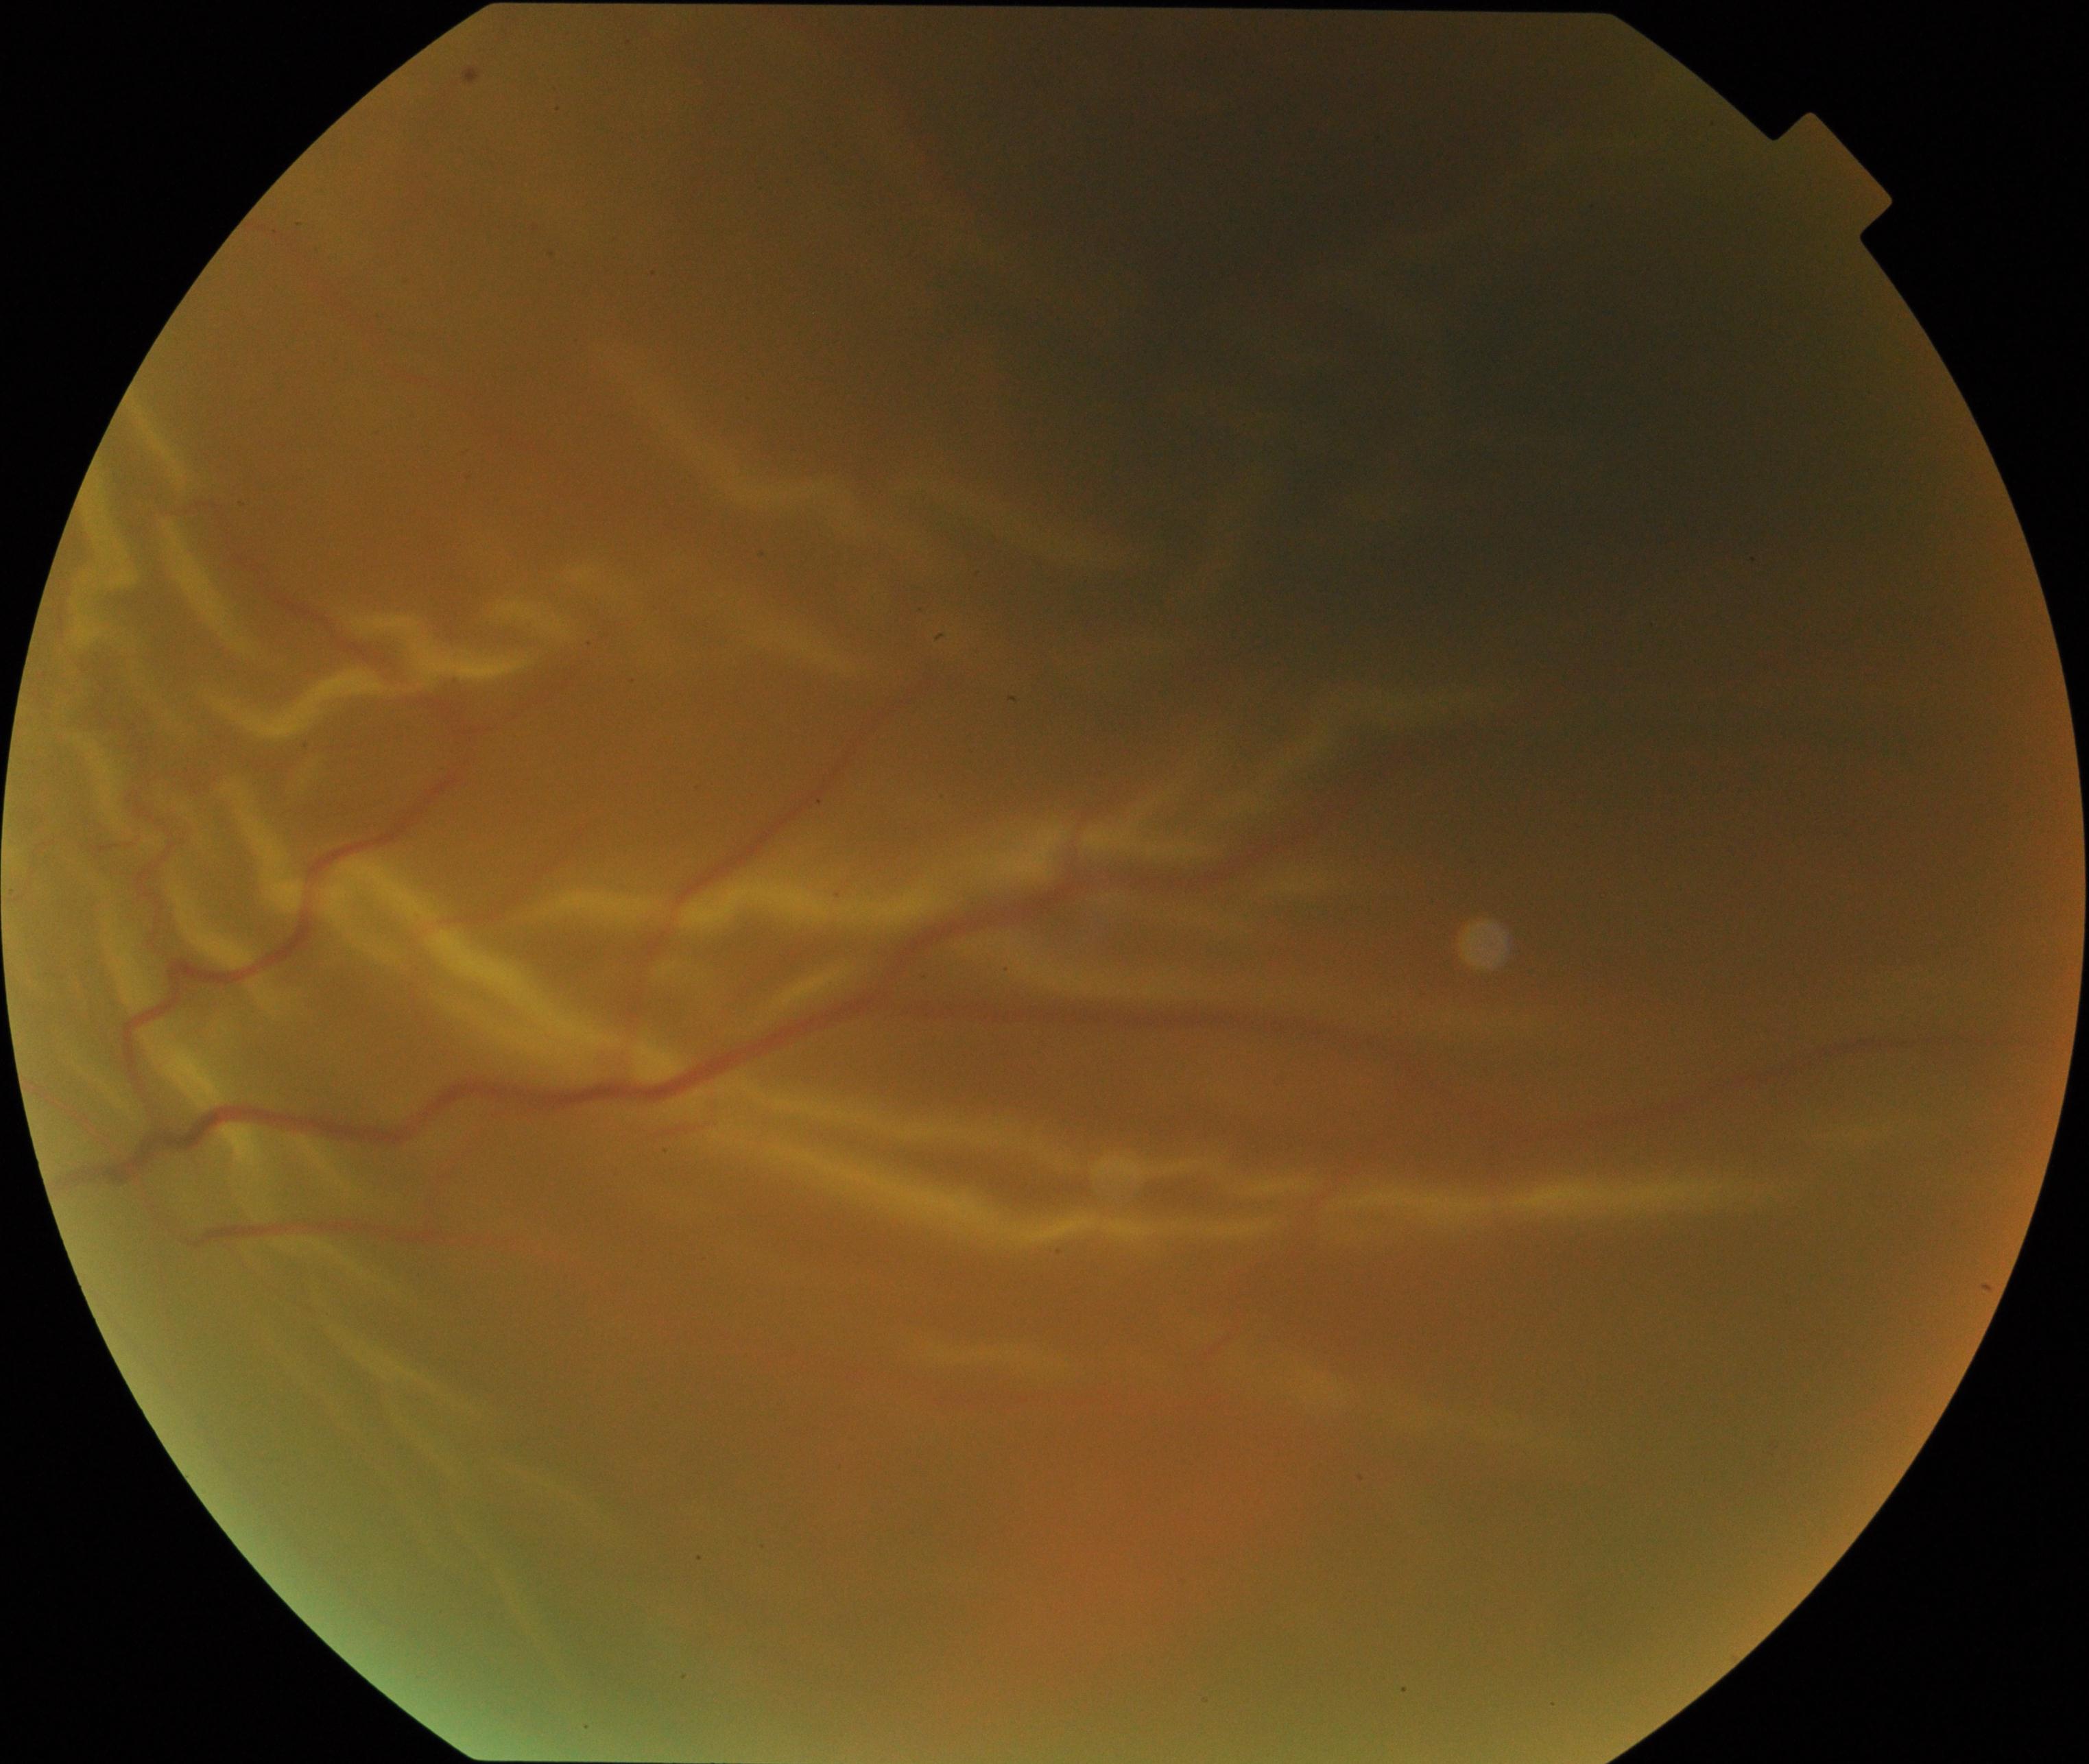 Impression: rhegmatogenous retinal detachment.